Camera: NIDEK AFC-230, no pharmacologic dilation, posterior pole color fundus photograph, modified Davis classification:
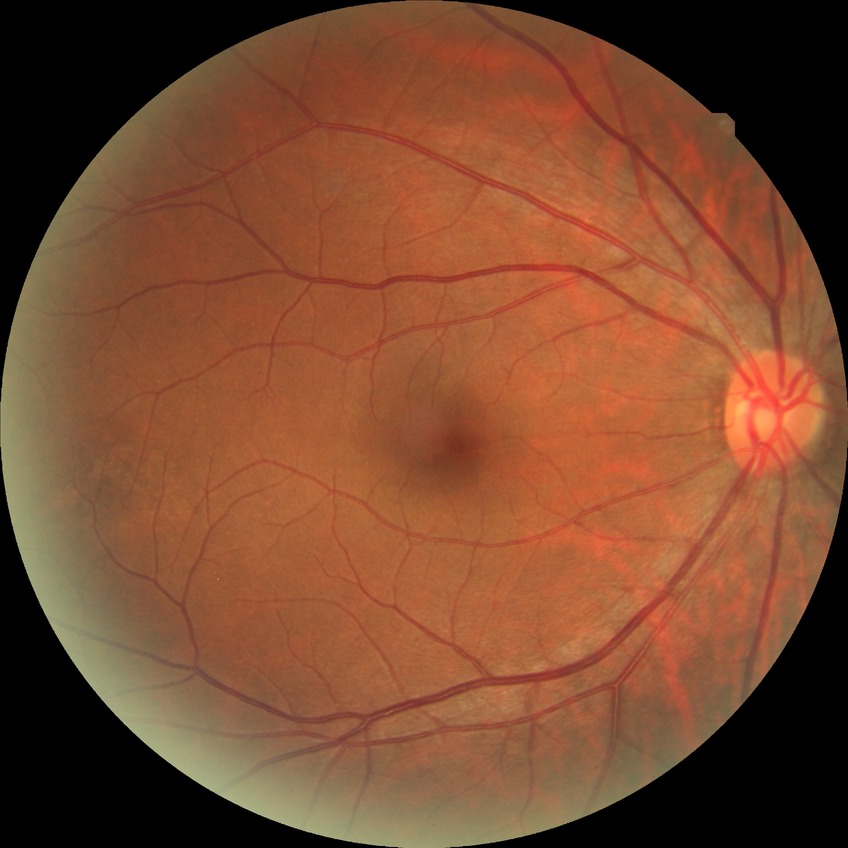 diabetic retinopathy (DR)=NDR (no diabetic retinopathy).